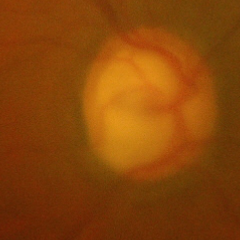
Fundus image with findings of severe glaucomatous damage.